Graded on the modified Davis scale. Acquired with a NIDEK AFC-230. 848x848px: 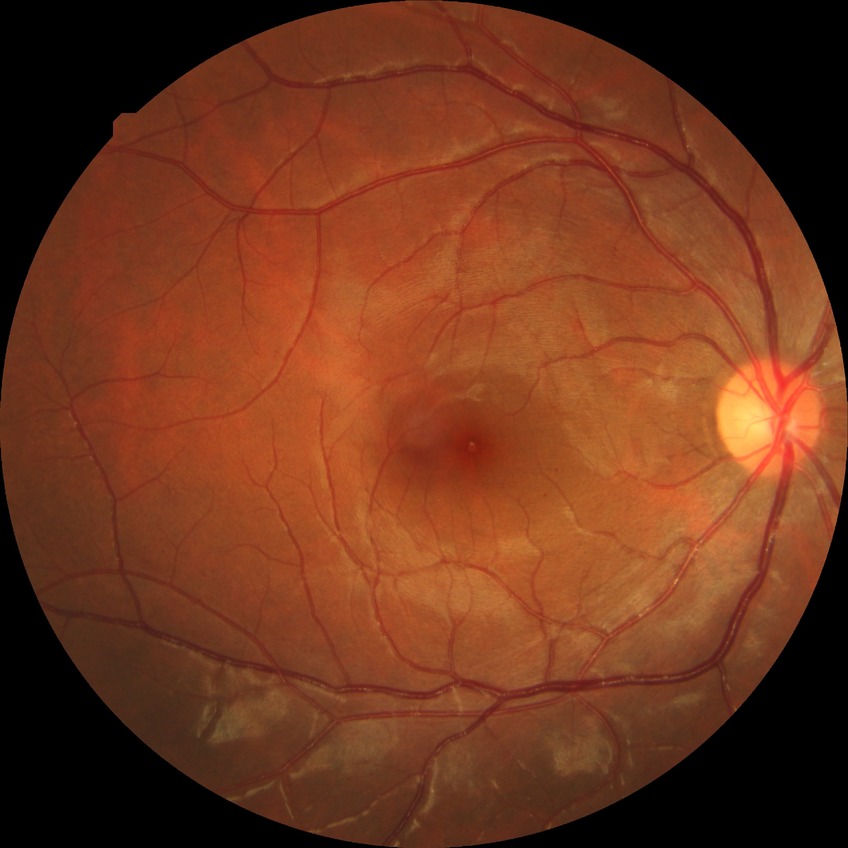
Modified Davis classification is no diabetic retinopathy.